Camera: Phoenix ICON (100° FOV); pediatric wide-field fundus photograph; 1240x1240.
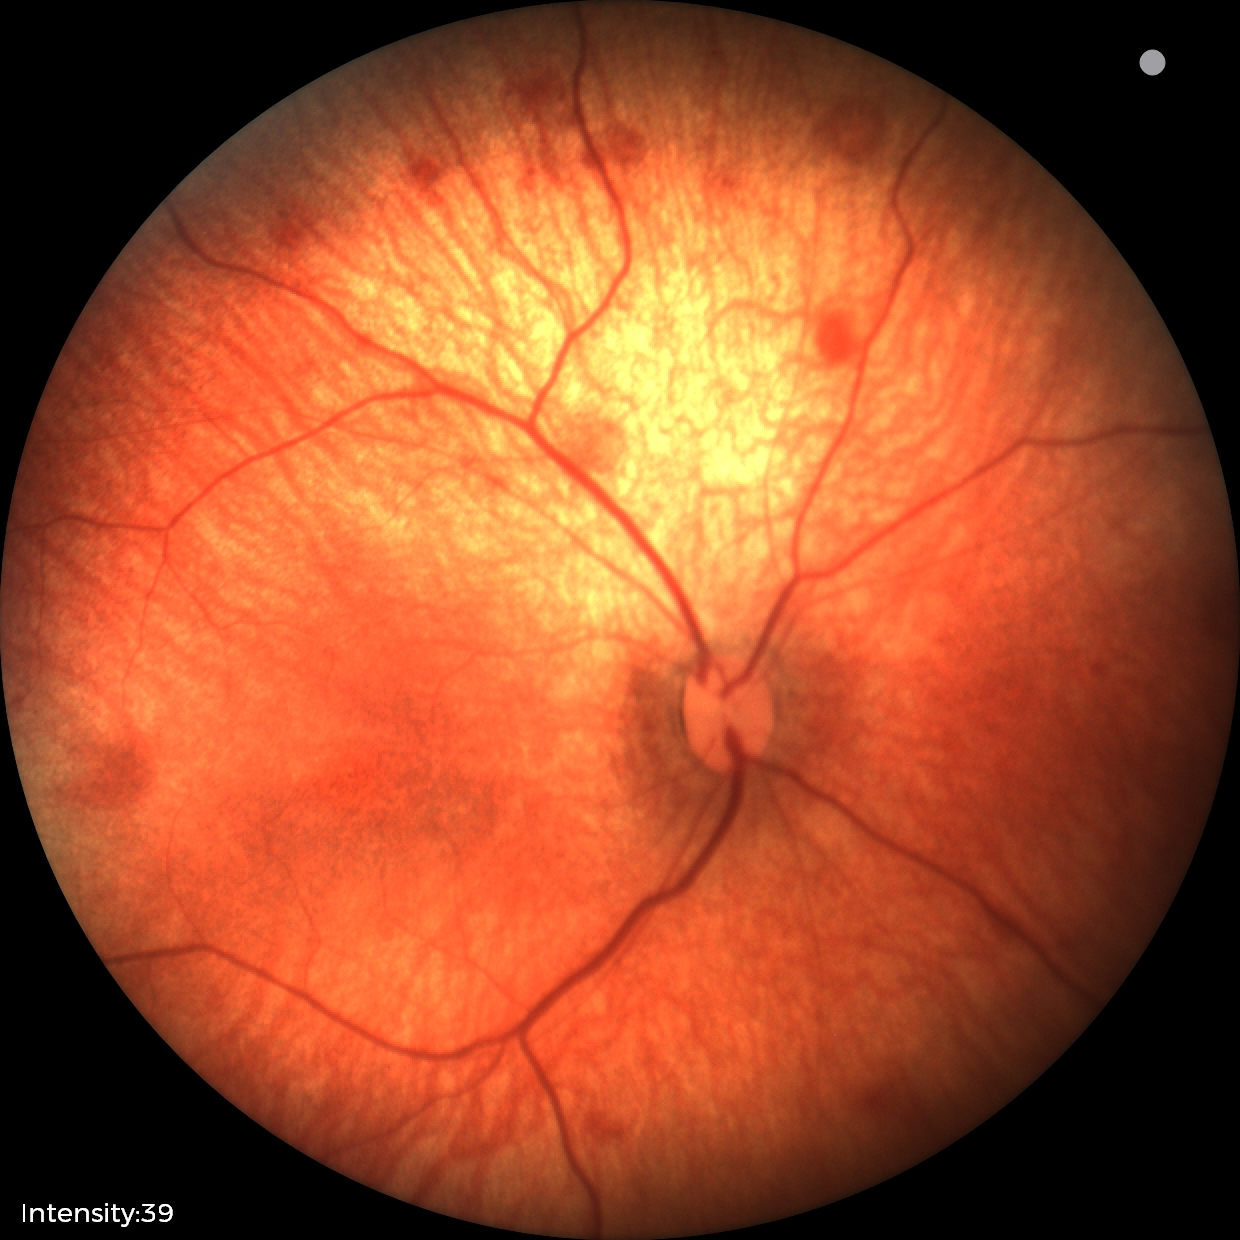
Screening series with retinal hemorrhages.